Camera: NIDEK AFC-230, modified Davis classification
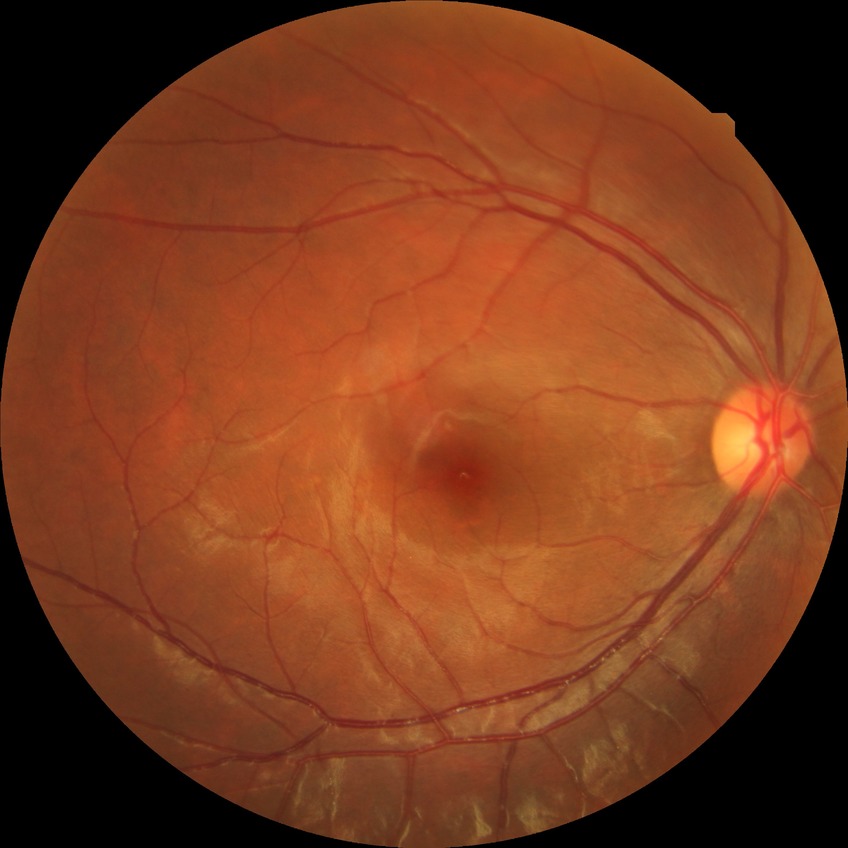 DR: SDR.